Modified Davis classification — 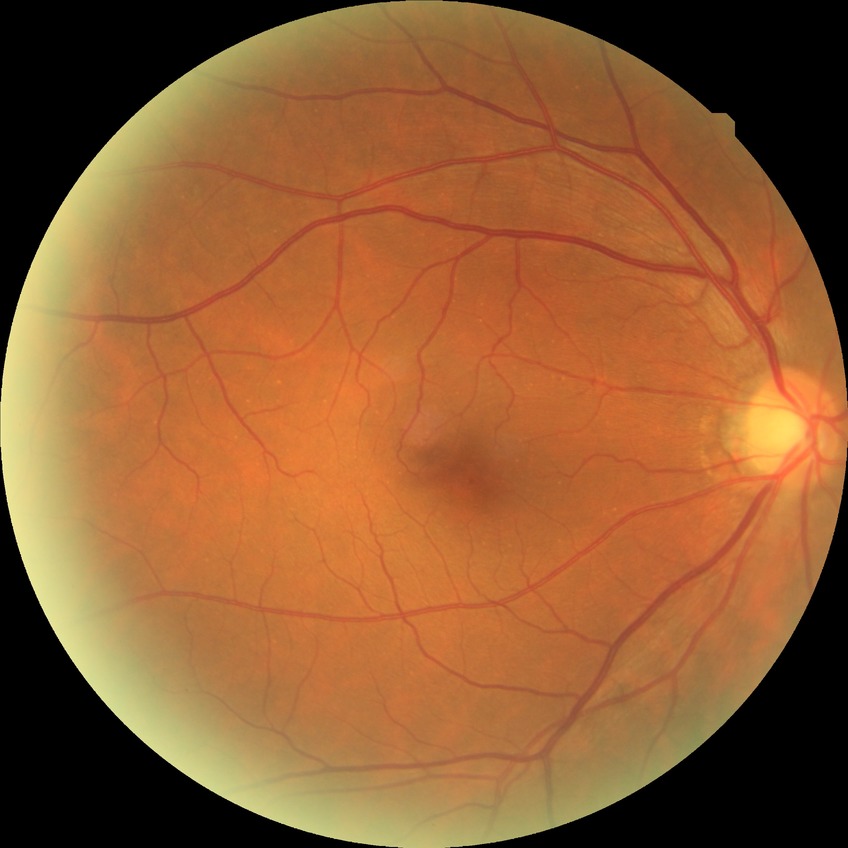
Diabetic retinopathy (DR): NDR (no diabetic retinopathy).